Wide-field fundus image from infant ROP screening: 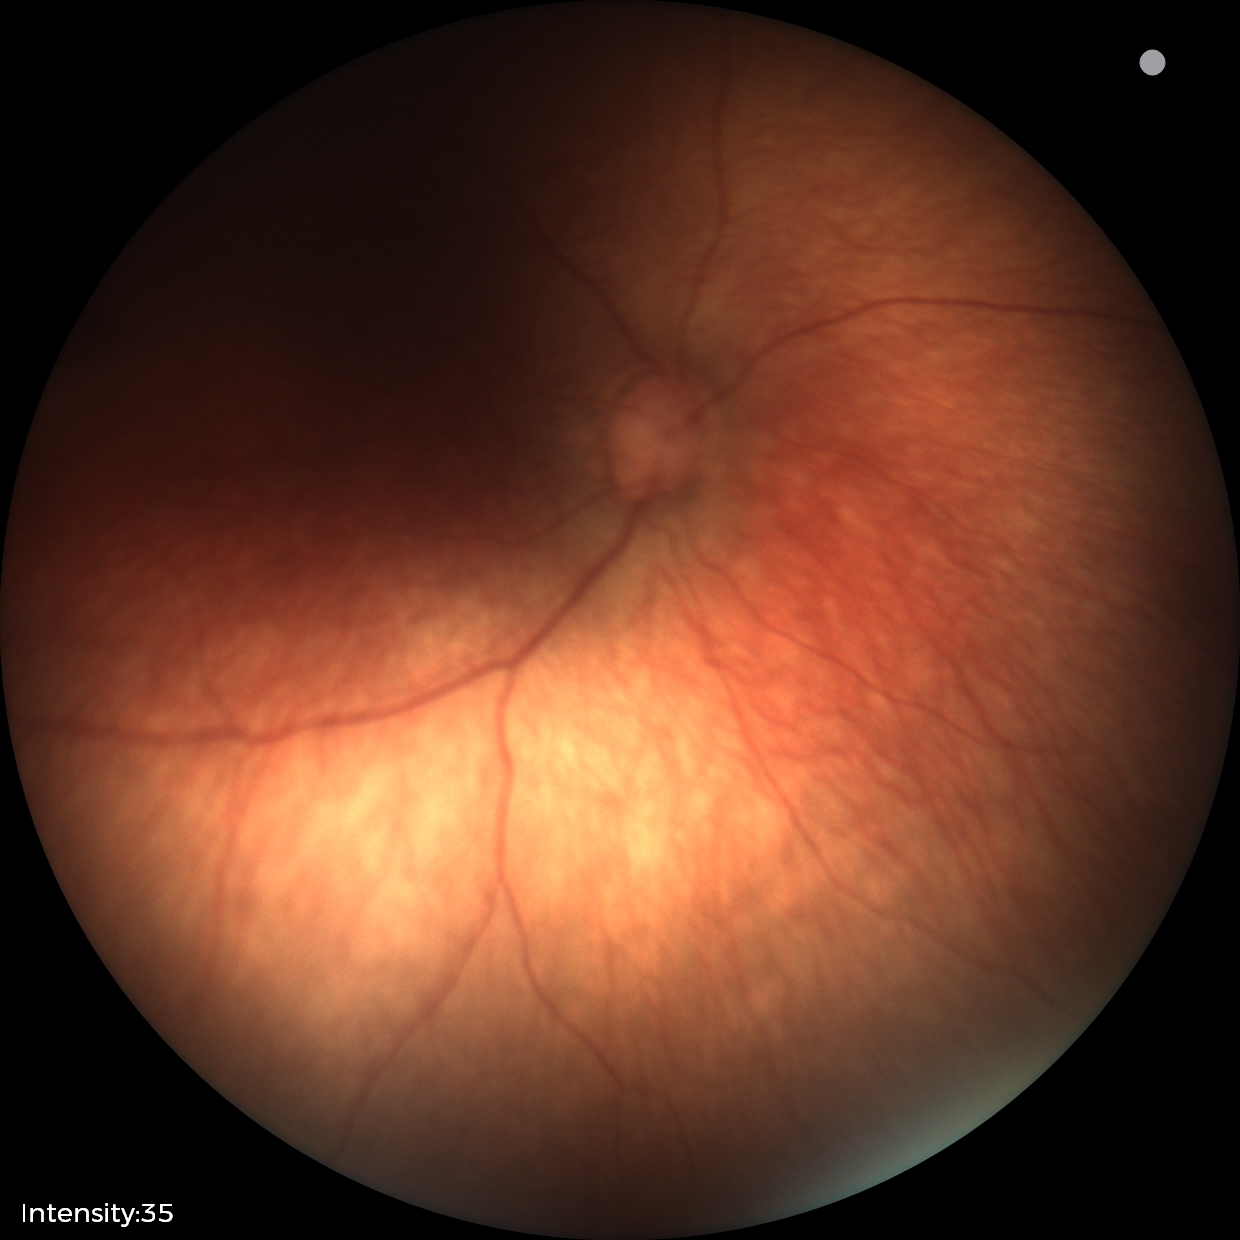

Physiological retinal appearance for postconceptual age.